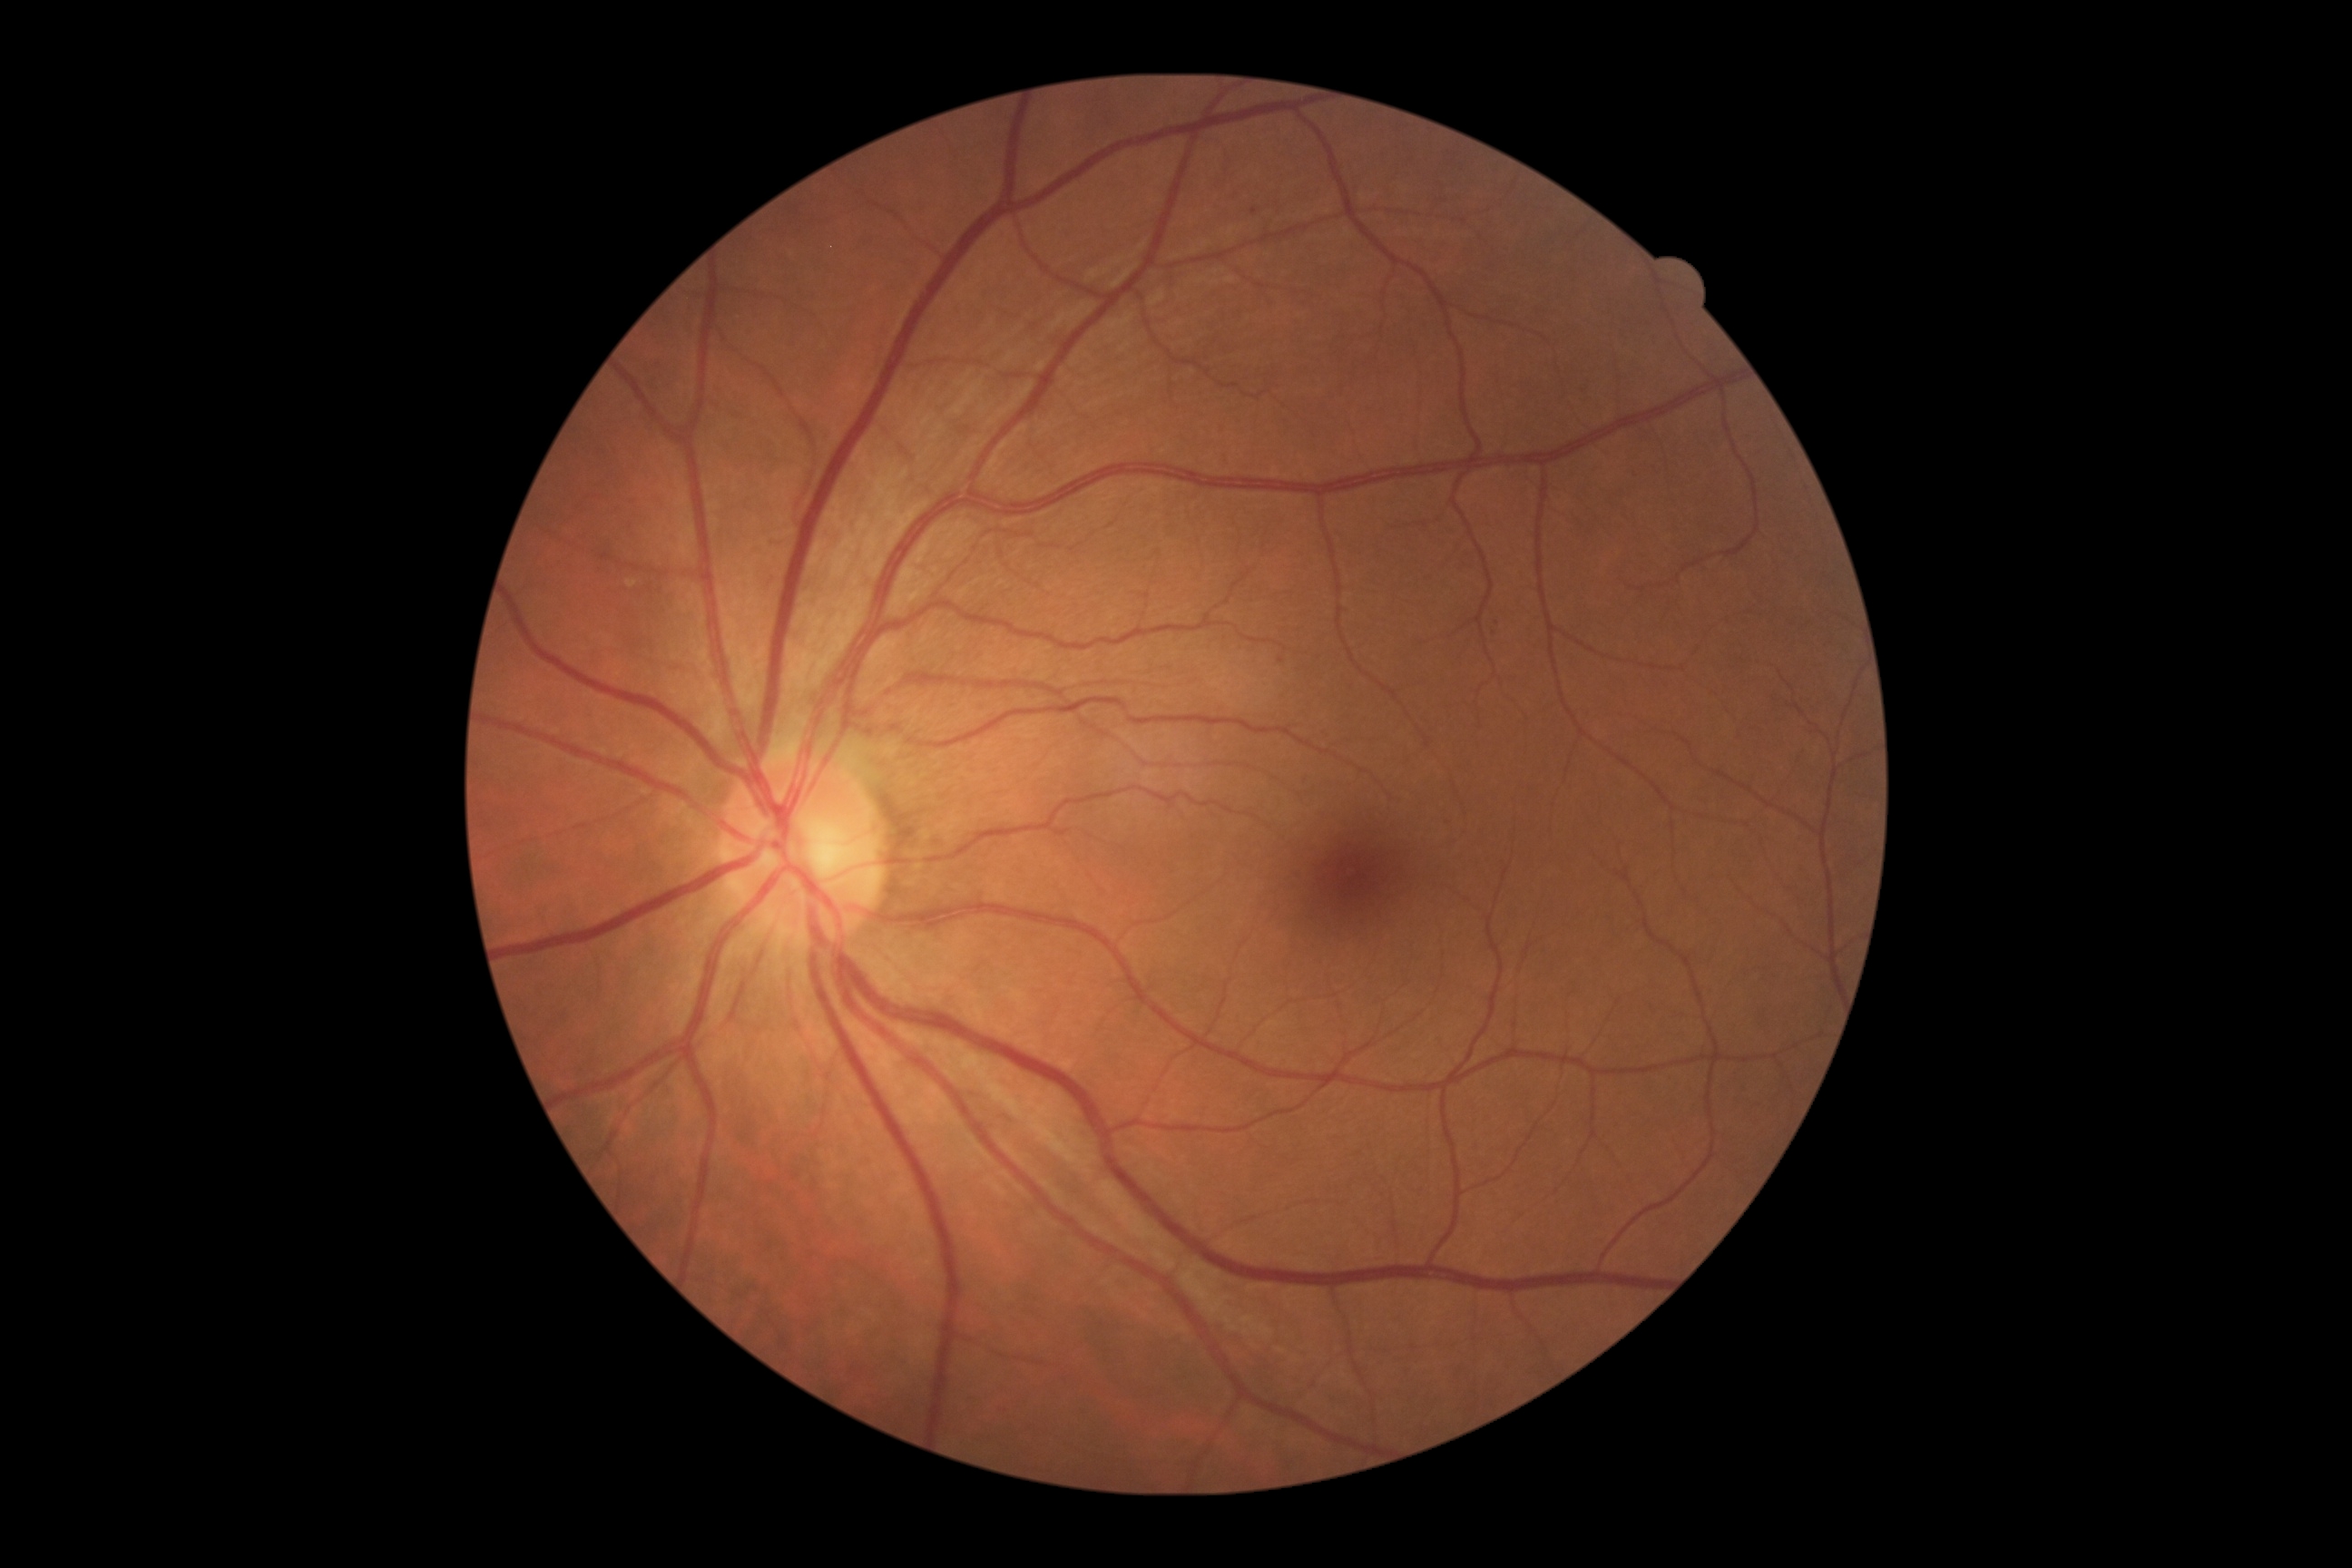
Diabetic retinopathy severity: grade 1 (mild NPDR).